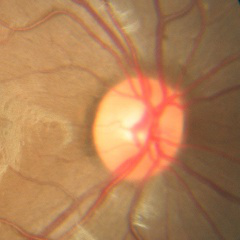

There is evidence of no glaucomatous changes.